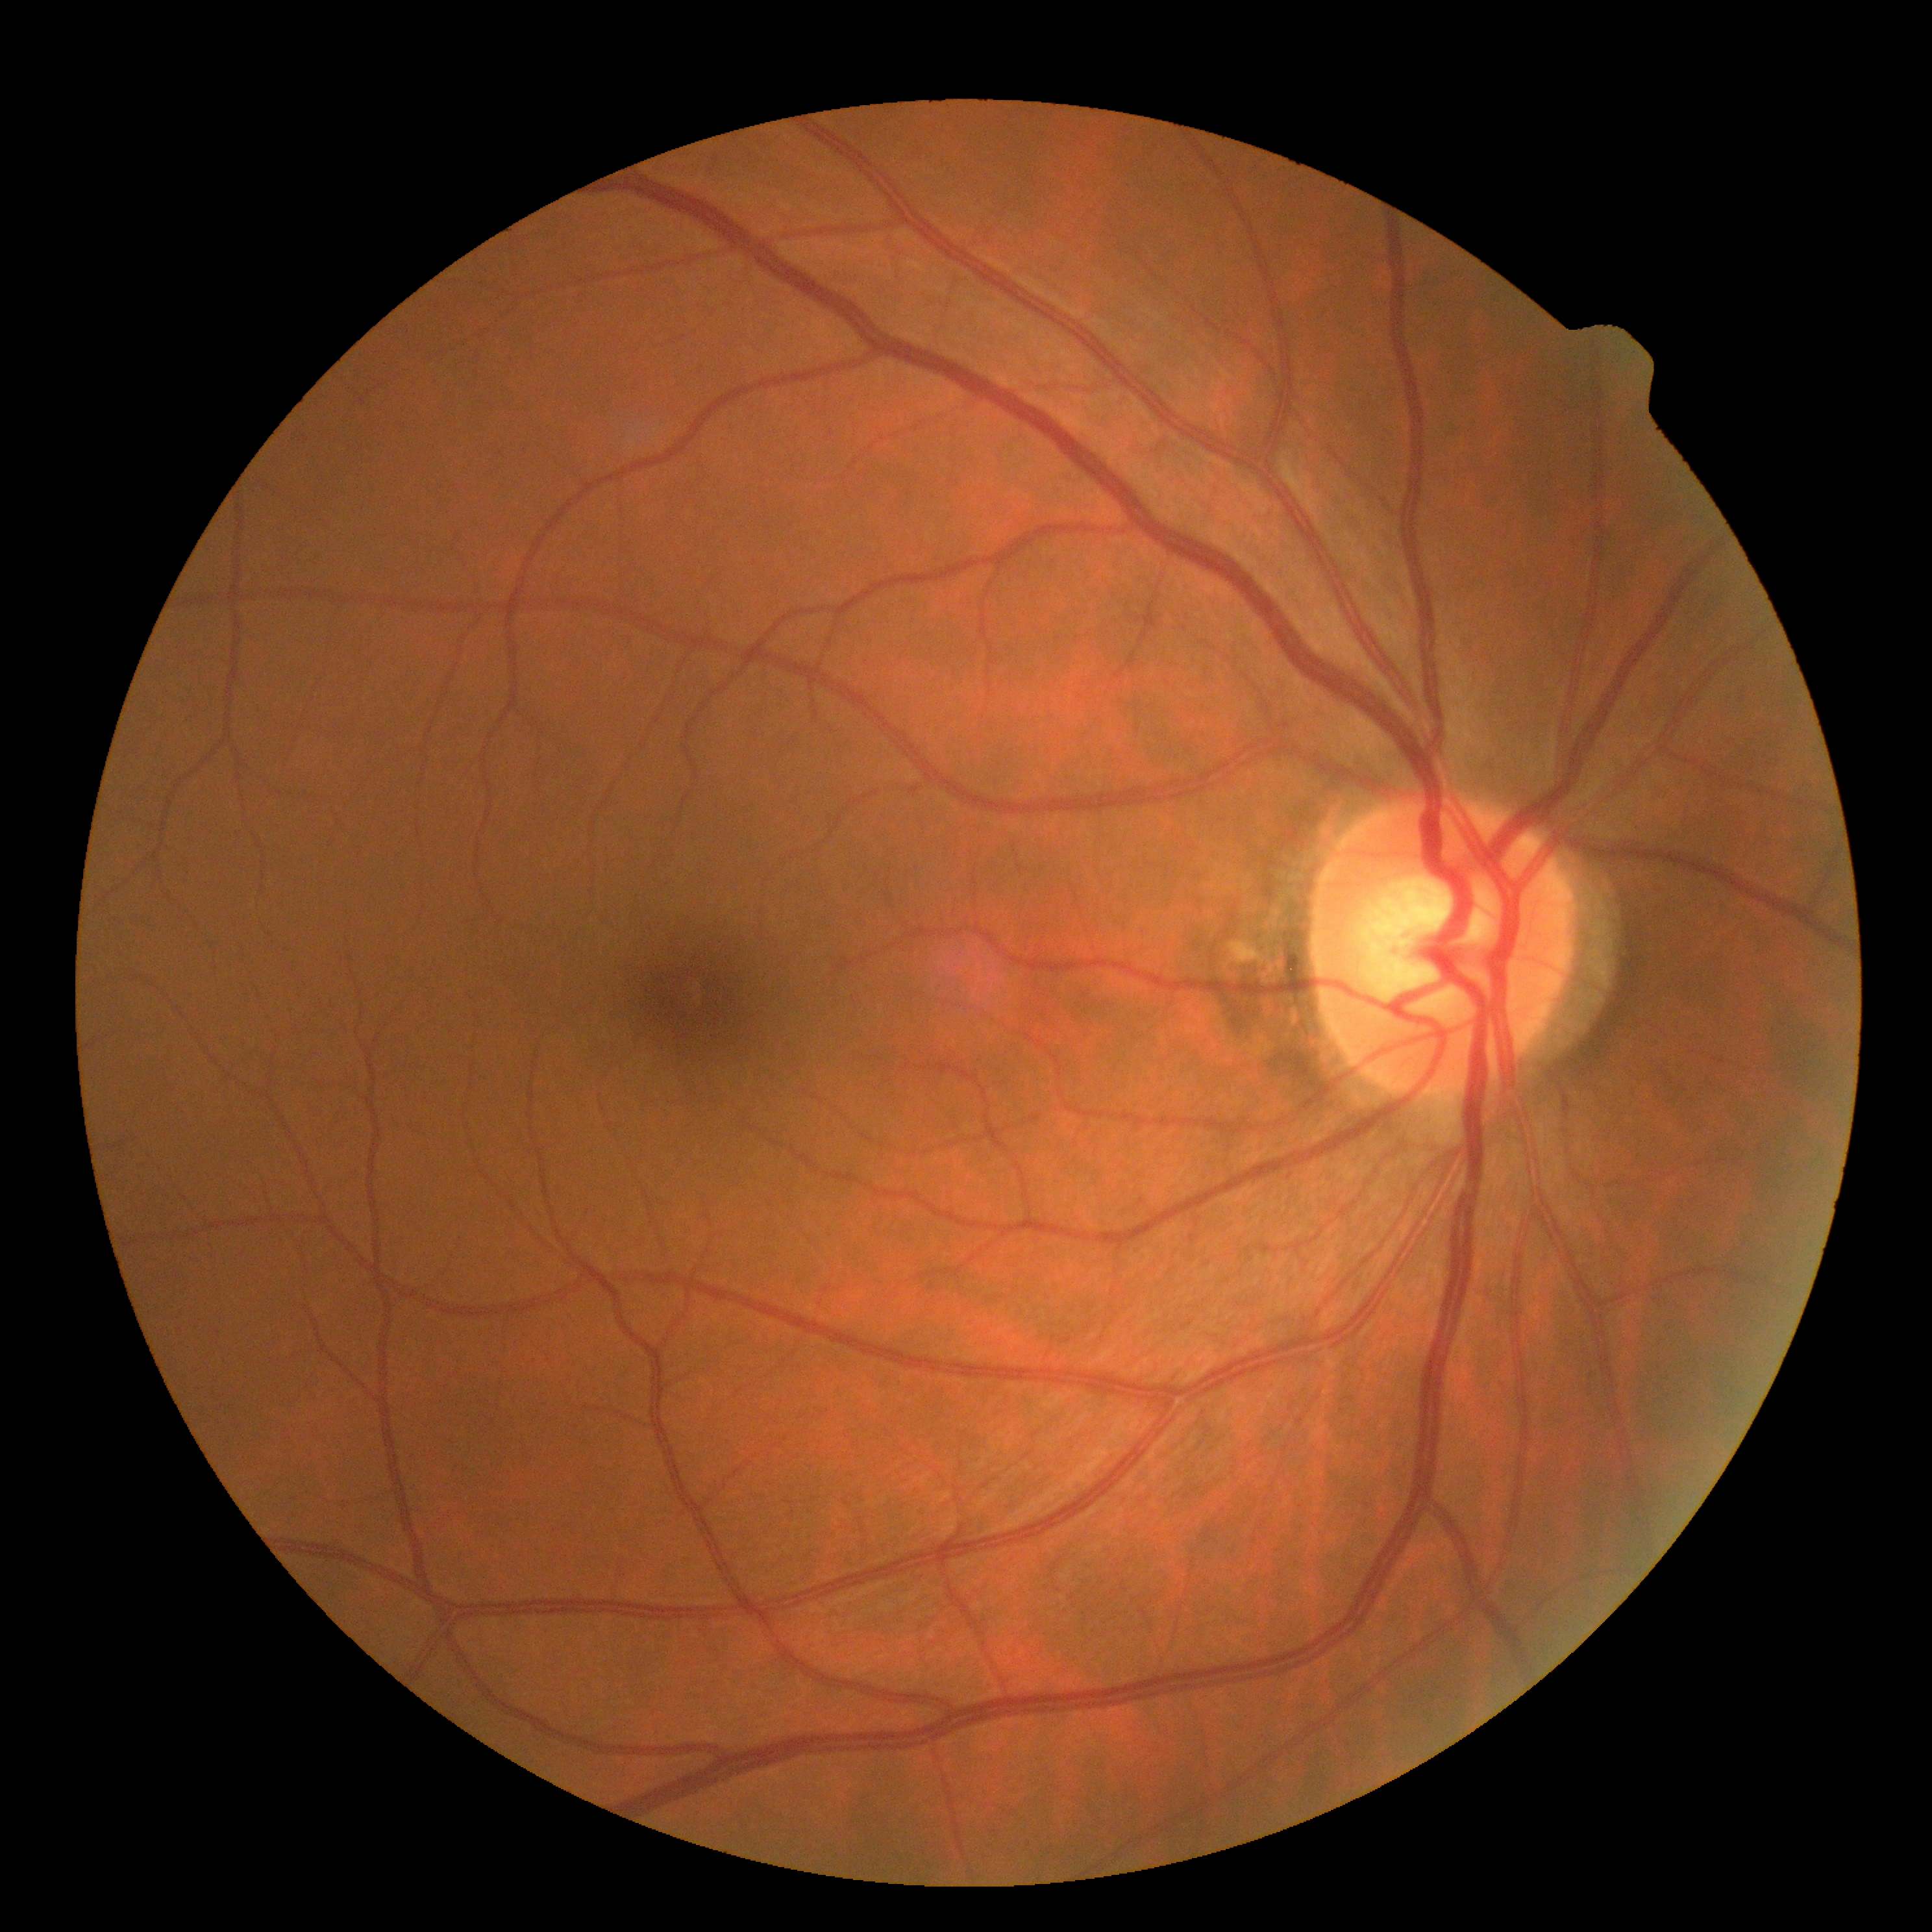

Diabetic retinopathy is no apparent diabetic retinopathy (grade 0).